45° field of view. 2212x1659. Retinal fundus photograph: 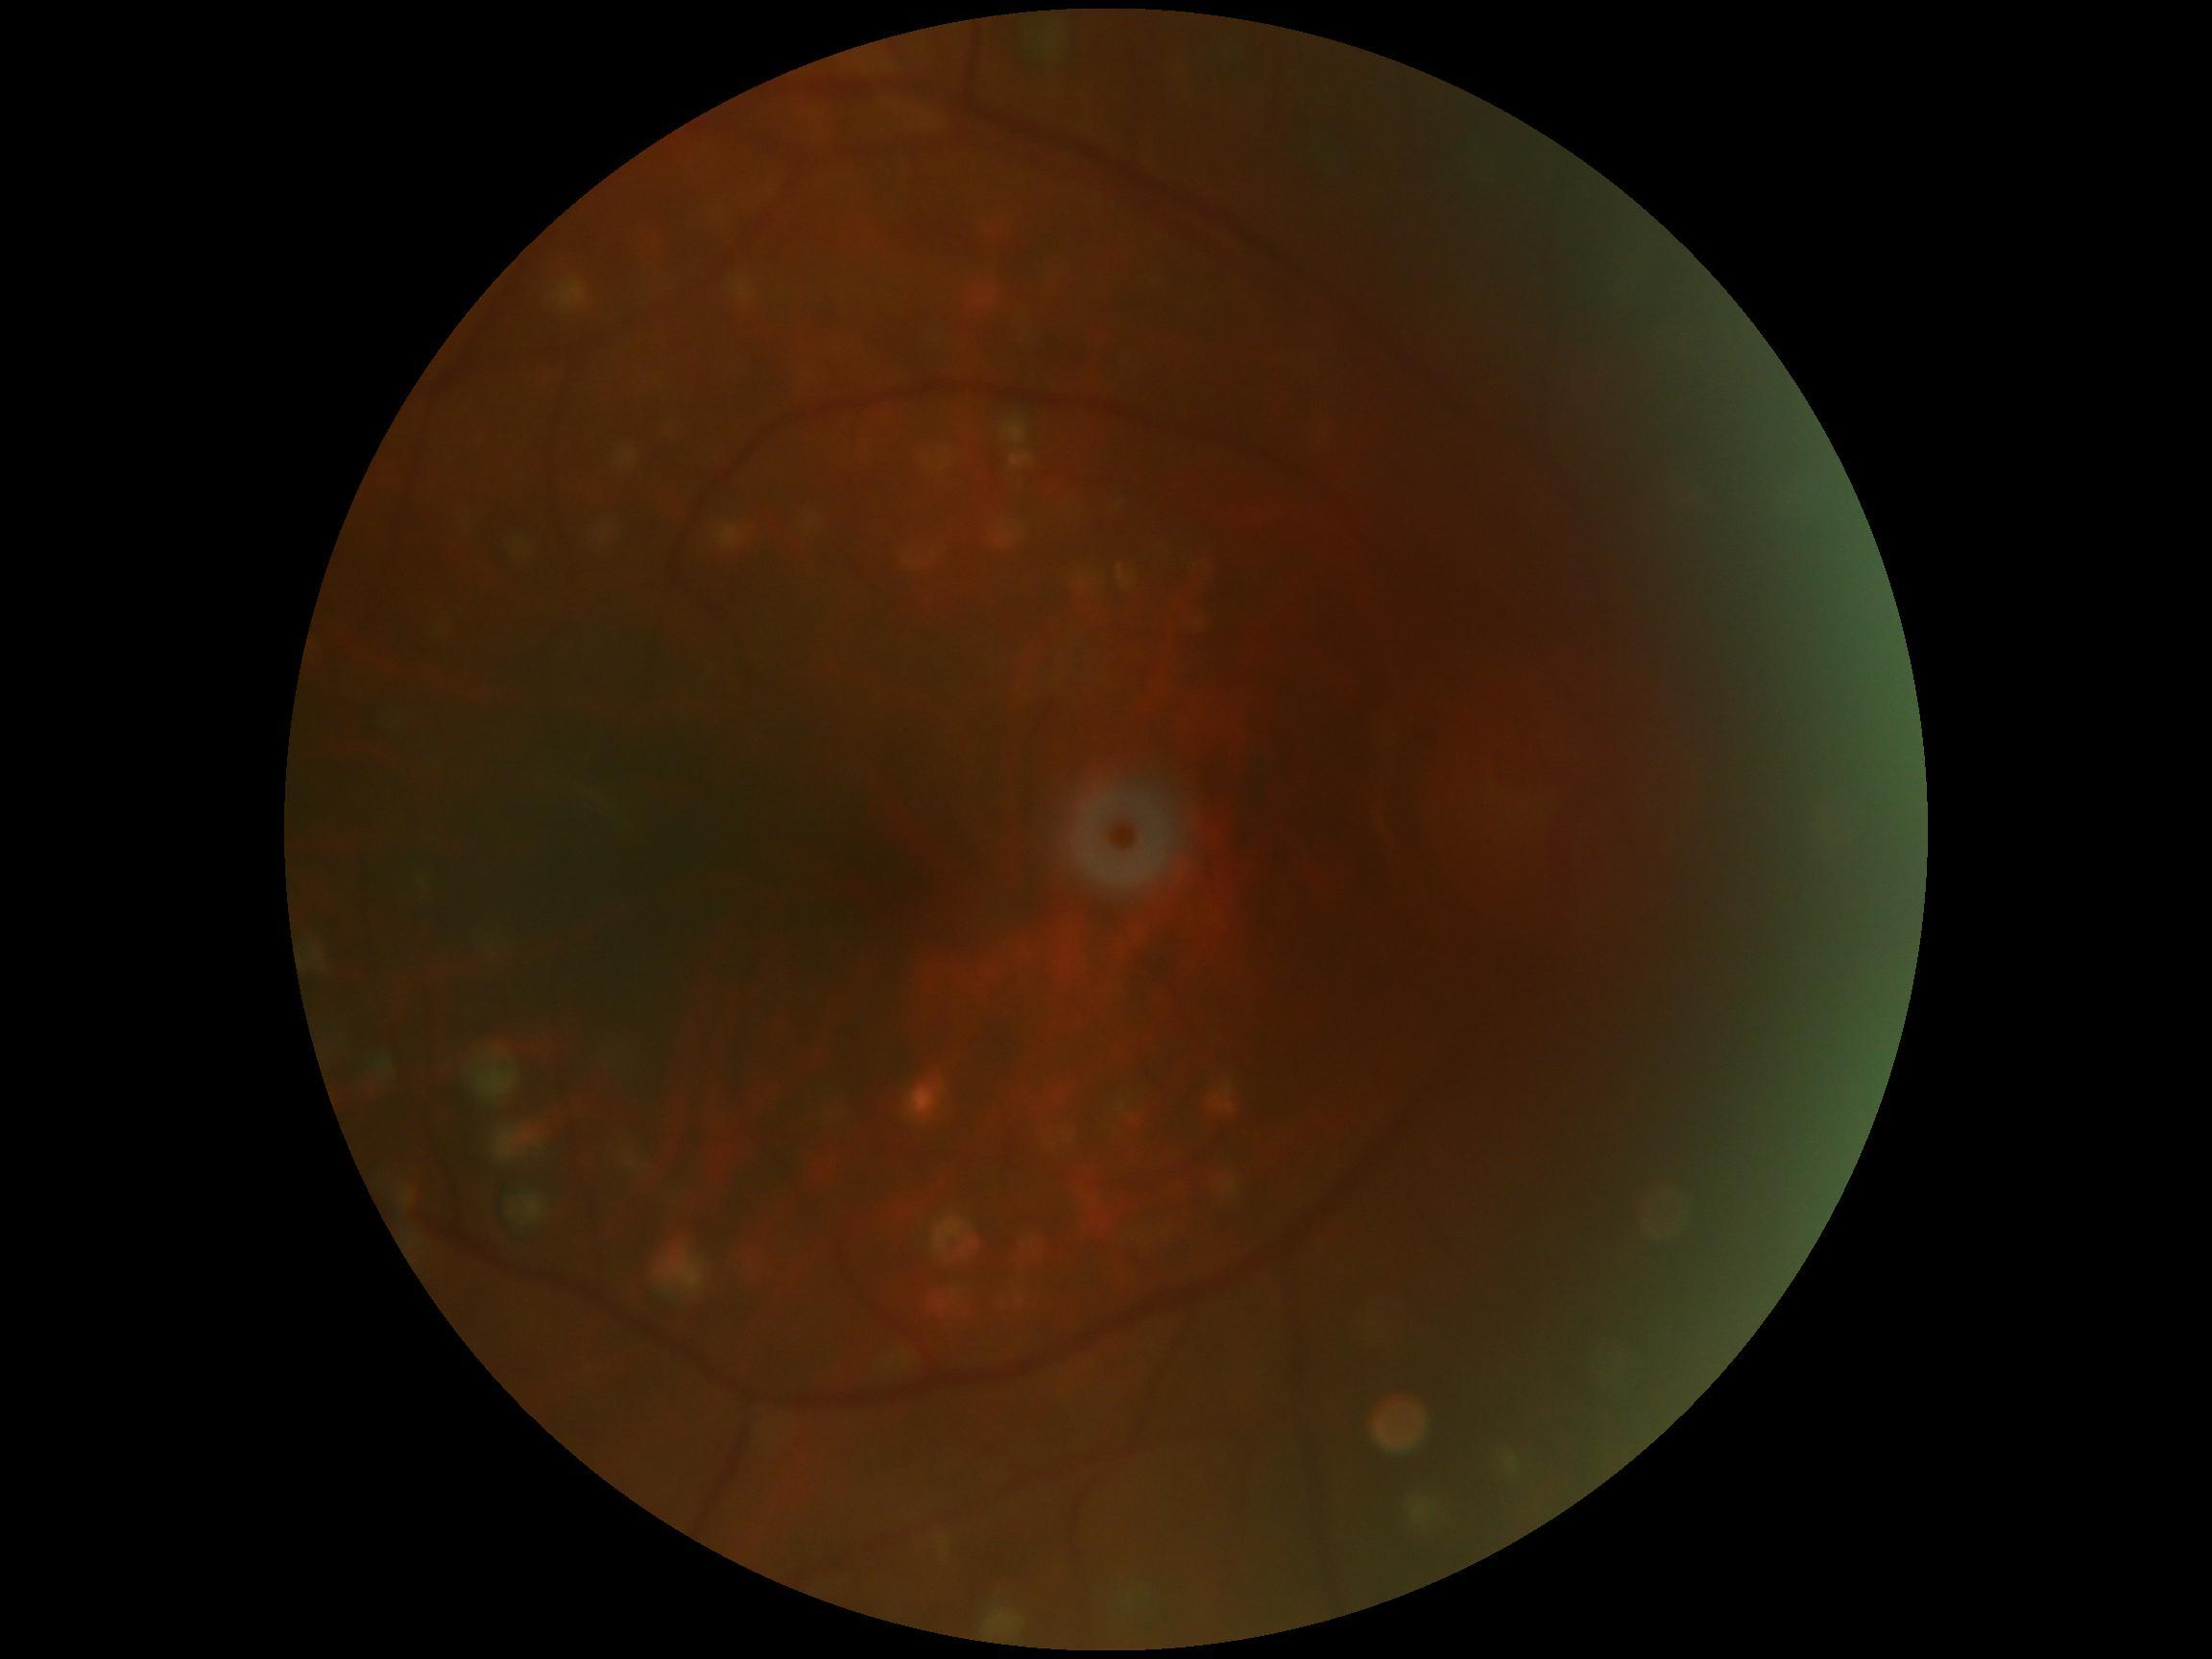
Diabetic retinopathy (DR): no apparent retinopathy (grade 0).